Topcon TRC retinal camera, IMAGEnet capture system, ONH-centered crop from a color fundus image
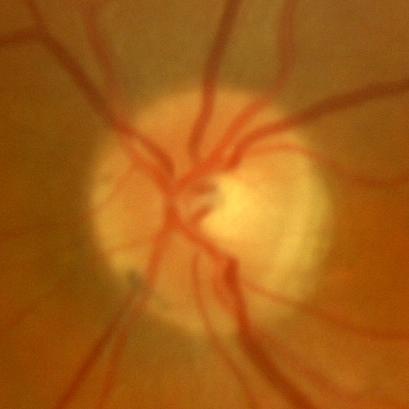

Demonstrates no glaucomatous optic neuropathy.